FOV: 45 degrees: 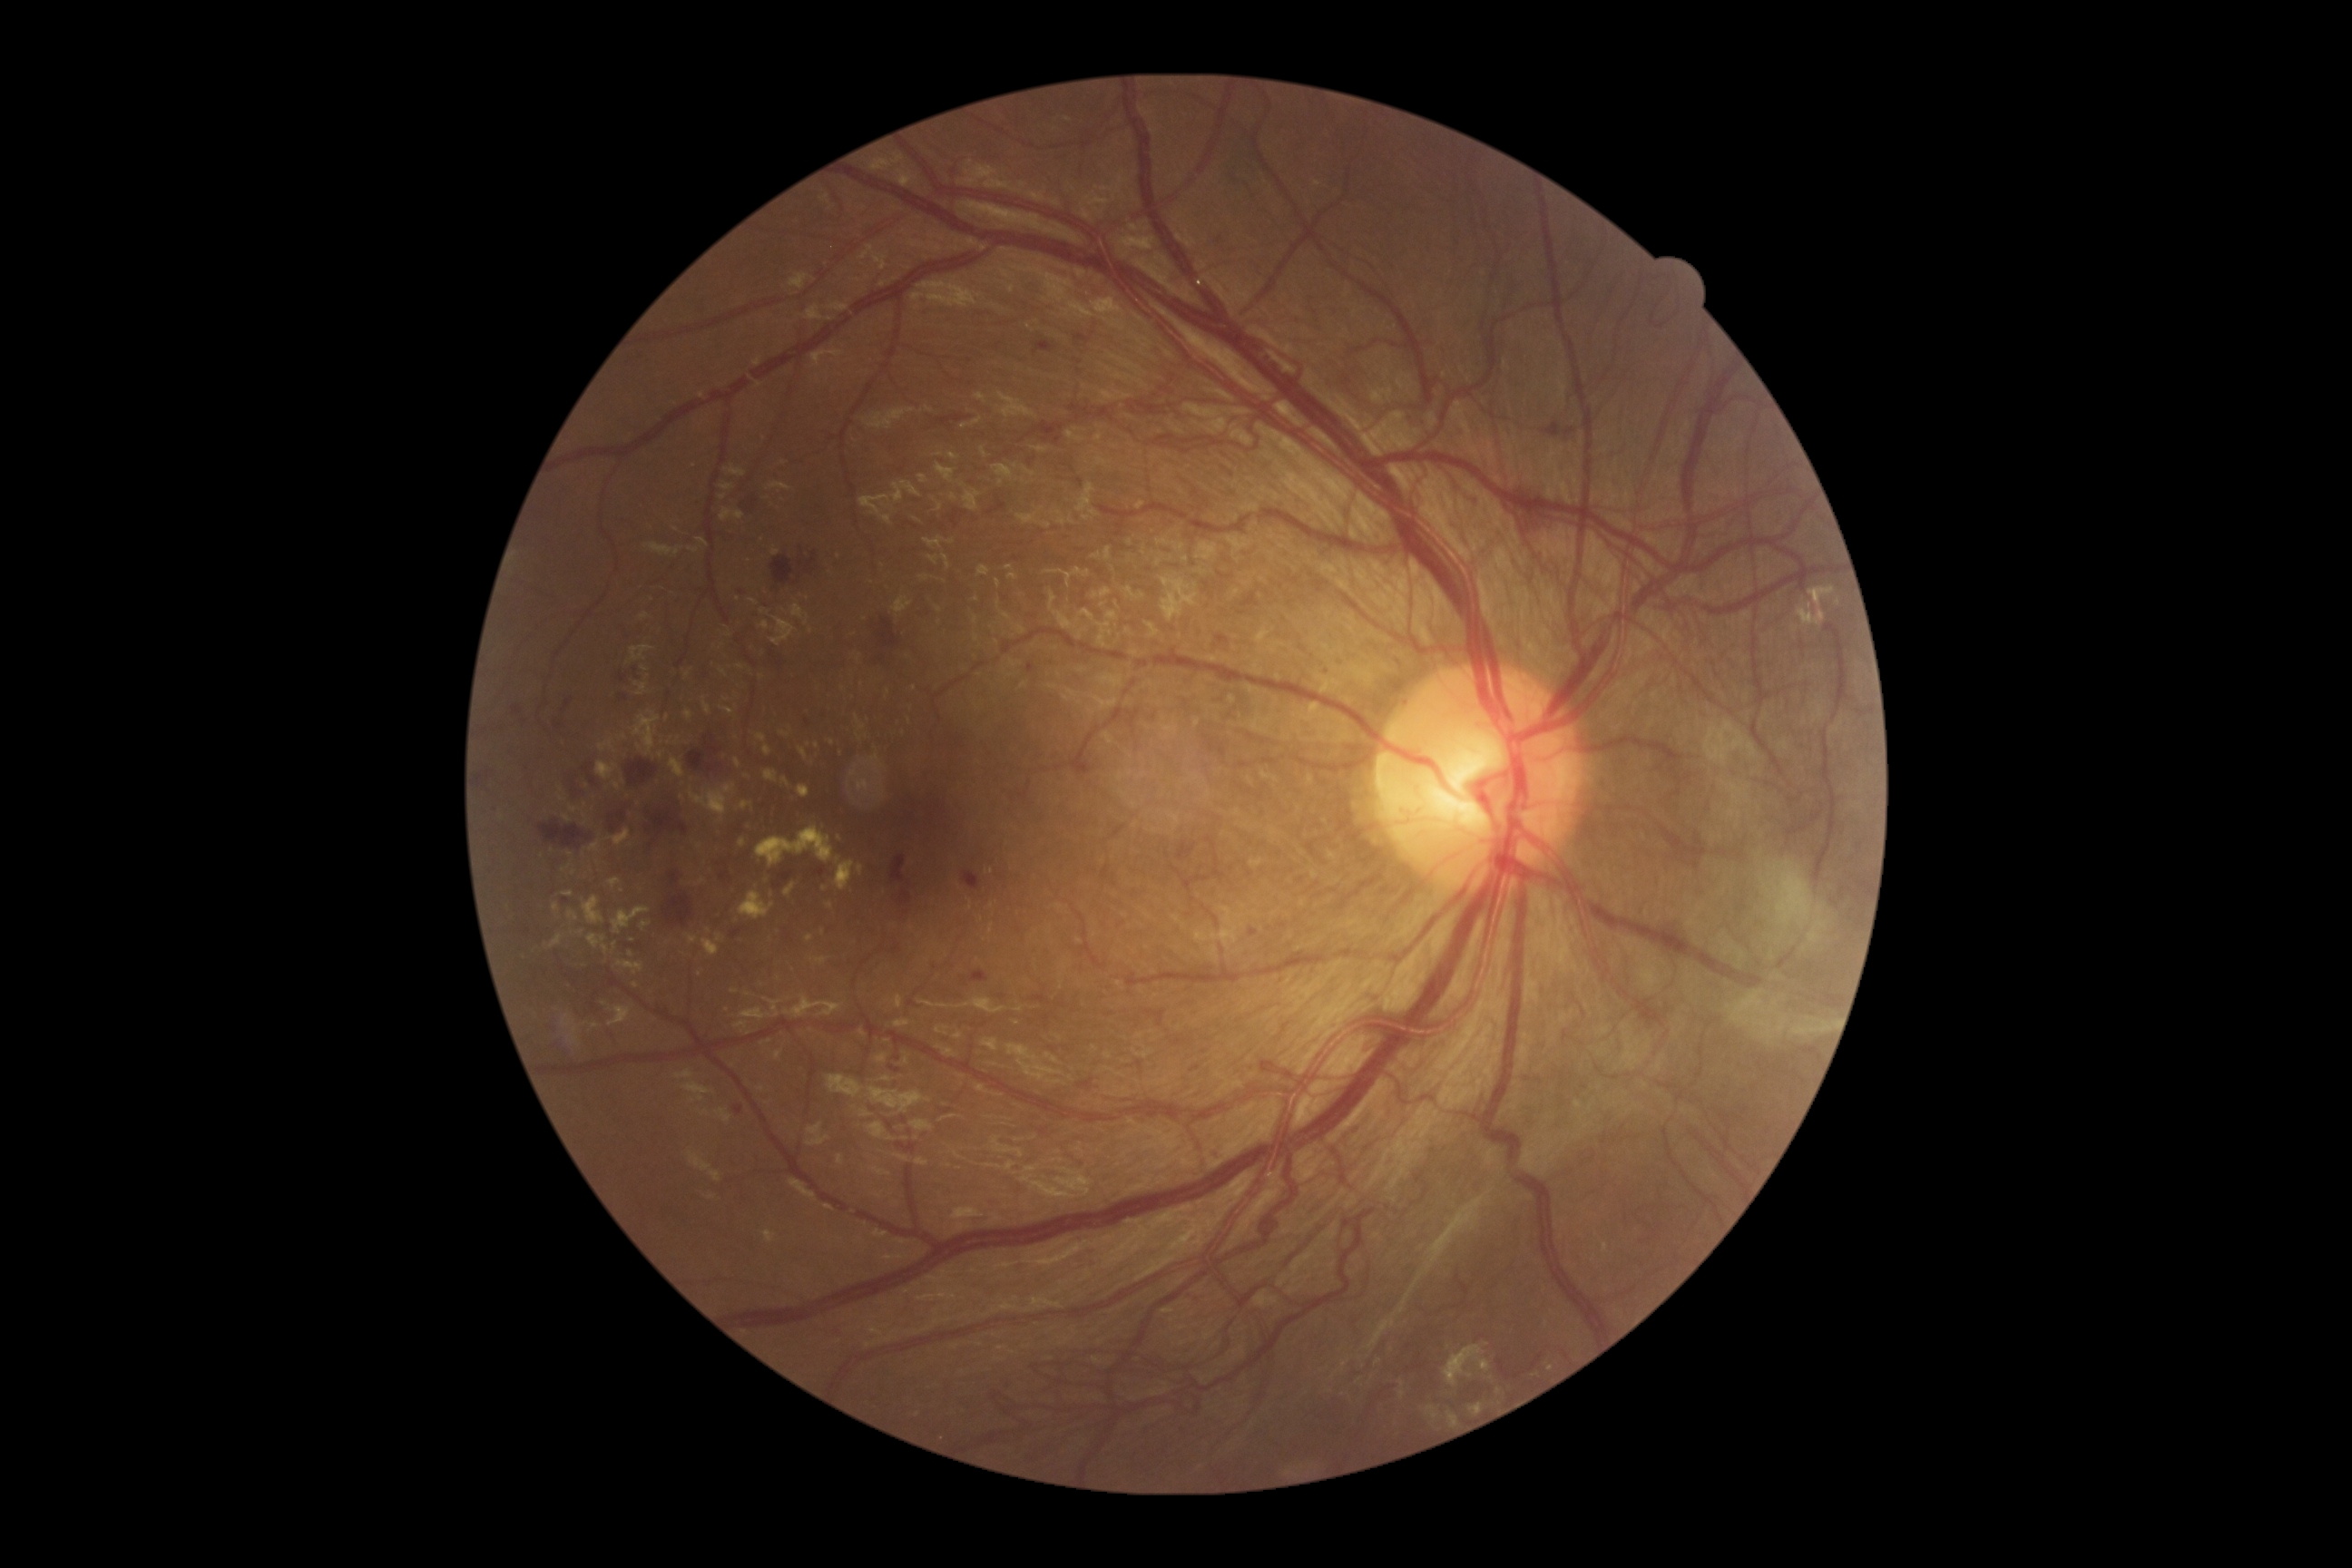

<lesions partial="true">
  <dr_grade>4</dr_grade>
  <he partial="true">816,867,827,877 | 609,812,625,832 | 877,618,899,649 | 1406,416,1431,435 | 1135,1121,1150,1126 | 908,1001,916,1006 | 567,760,605,796 | 899,890,912,908 | 480,772,493,787 | 779,872,794,883 | 1204,736,1228,758 | 1250,930,1259,937 | 952,509,959,529 | 720,872,730,881 | 663,896,692,926</he>
  <he_small_centers>[1283,925] | [801,564]</he_small_centers>
  <ex partial="true">858,654,861,662 | 738,839,747,848 | 765,770,778,783 | 1602,1244,1609,1253 | 850,754,887,801 | 834,858,856,890 | 671,760,685,778 | 856,716,865,730 | 618,961,643,975 | 858,865,865,876 | 642,921,651,932</ex>
  <ex_small_centers>[727,701] | [596,1025] | [762,677] | [623,783] | [542,856] | [1810,607] | [584,815] | [823,932]</ex_small_centers>
</lesions>